Fundus photo; 848 x 848 pixels; no pharmacologic dilation — 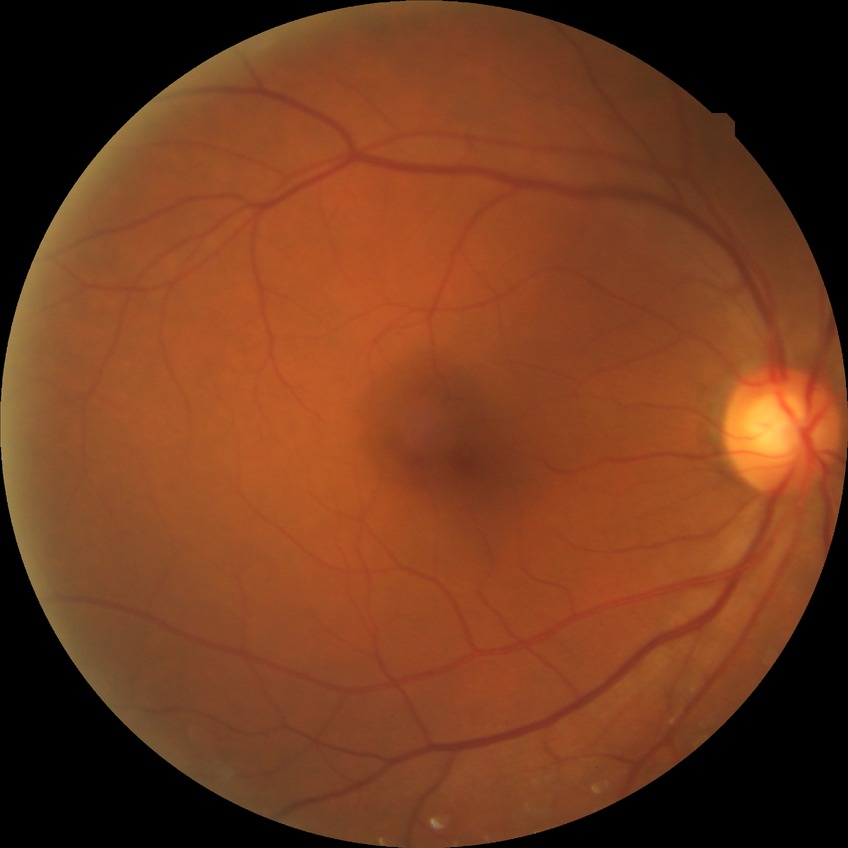
diabetic retinopathy (DR): no diabetic retinopathy (NDR).